RetCam wide-field infant fundus image; camera: Clarity RetCam 3 (130° FOV): 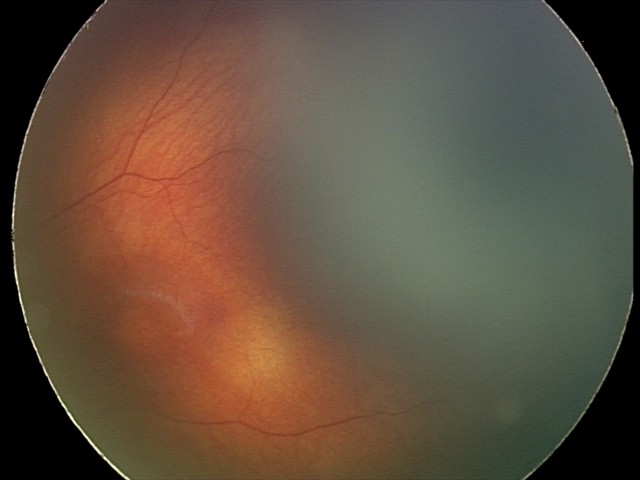

Normal screening examination.